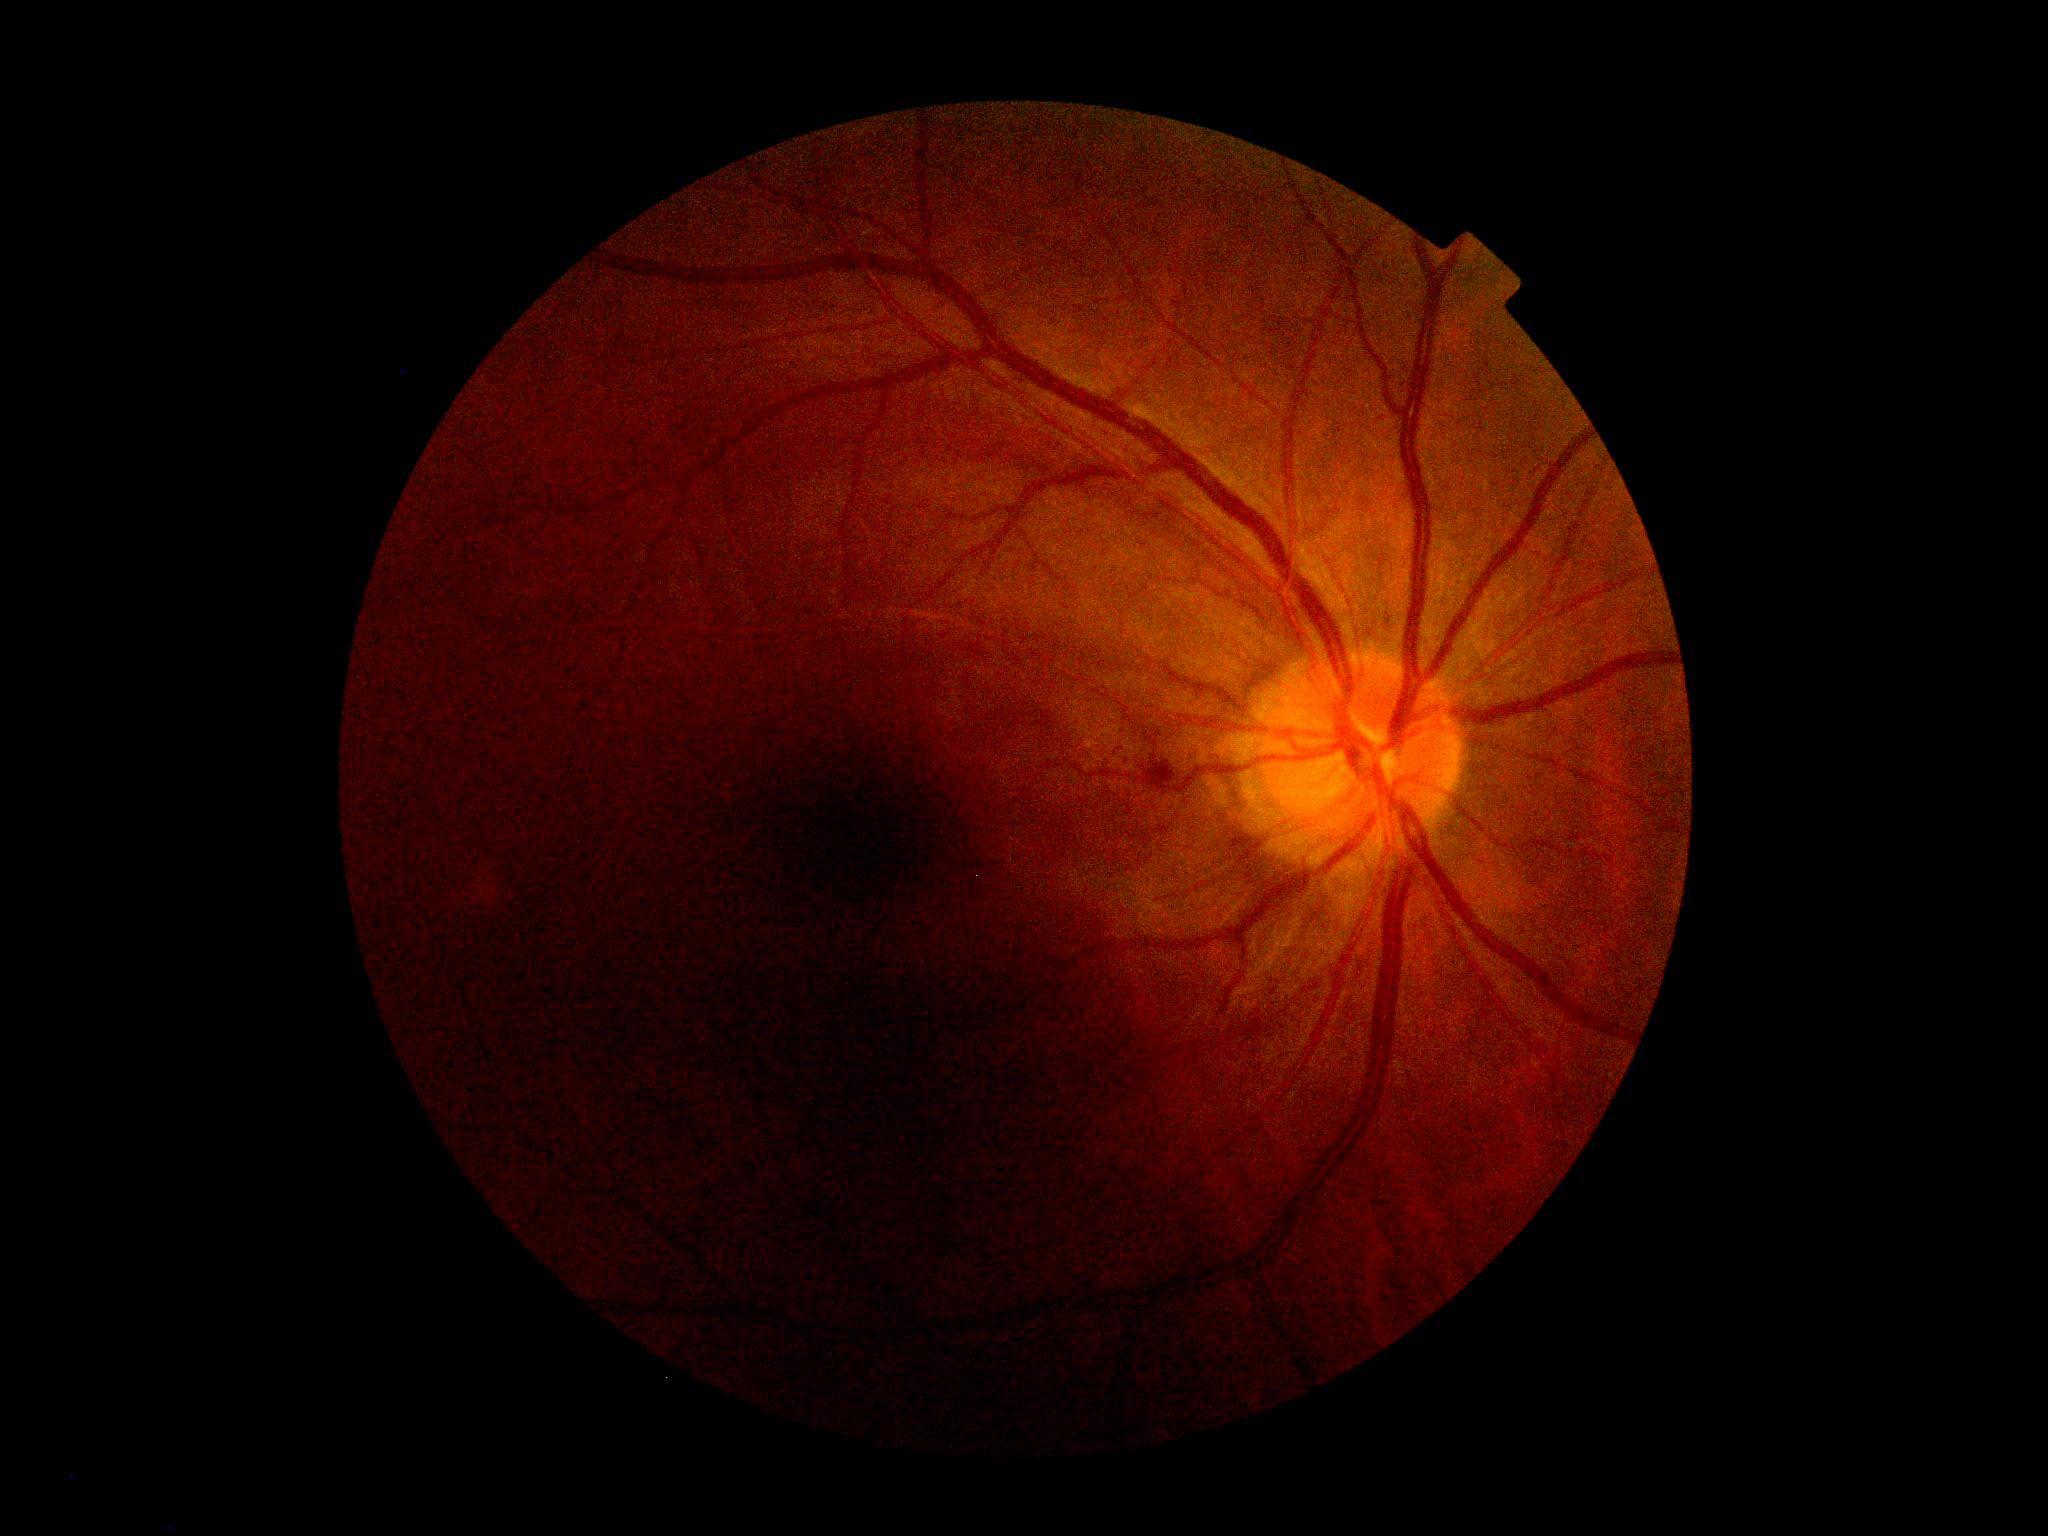 Diabetic retinopathy is grade 2 — more than just microaneurysms but less than severe NPDR.